Color fundus photograph
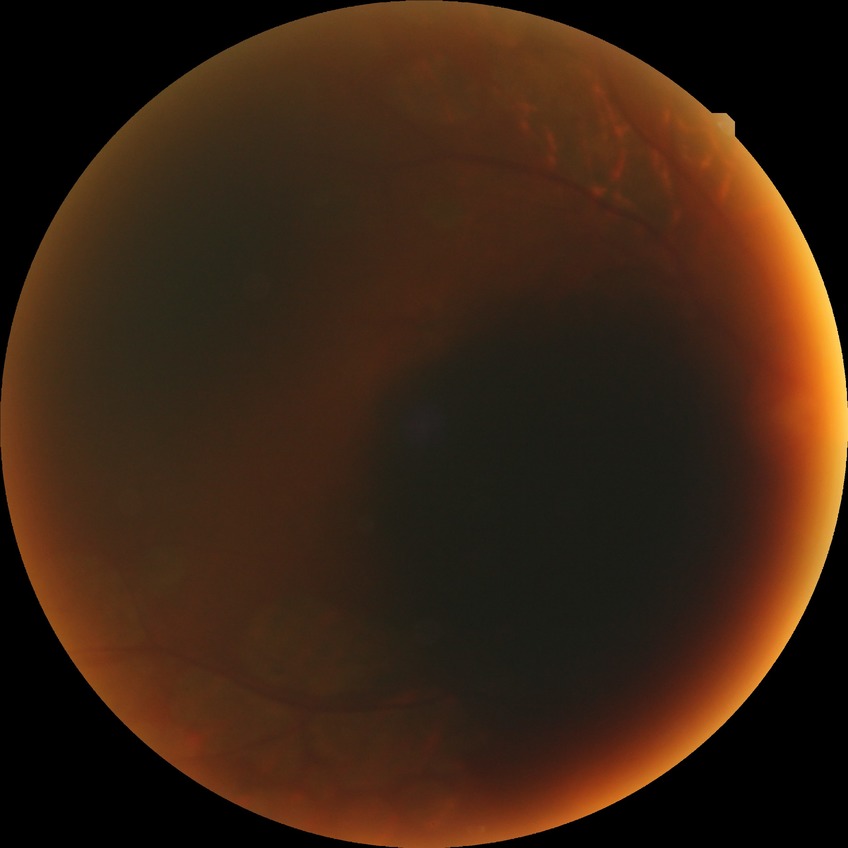 Annotations:
- DR stage: PDR